2048 by 1536 pixels; 45° field of view
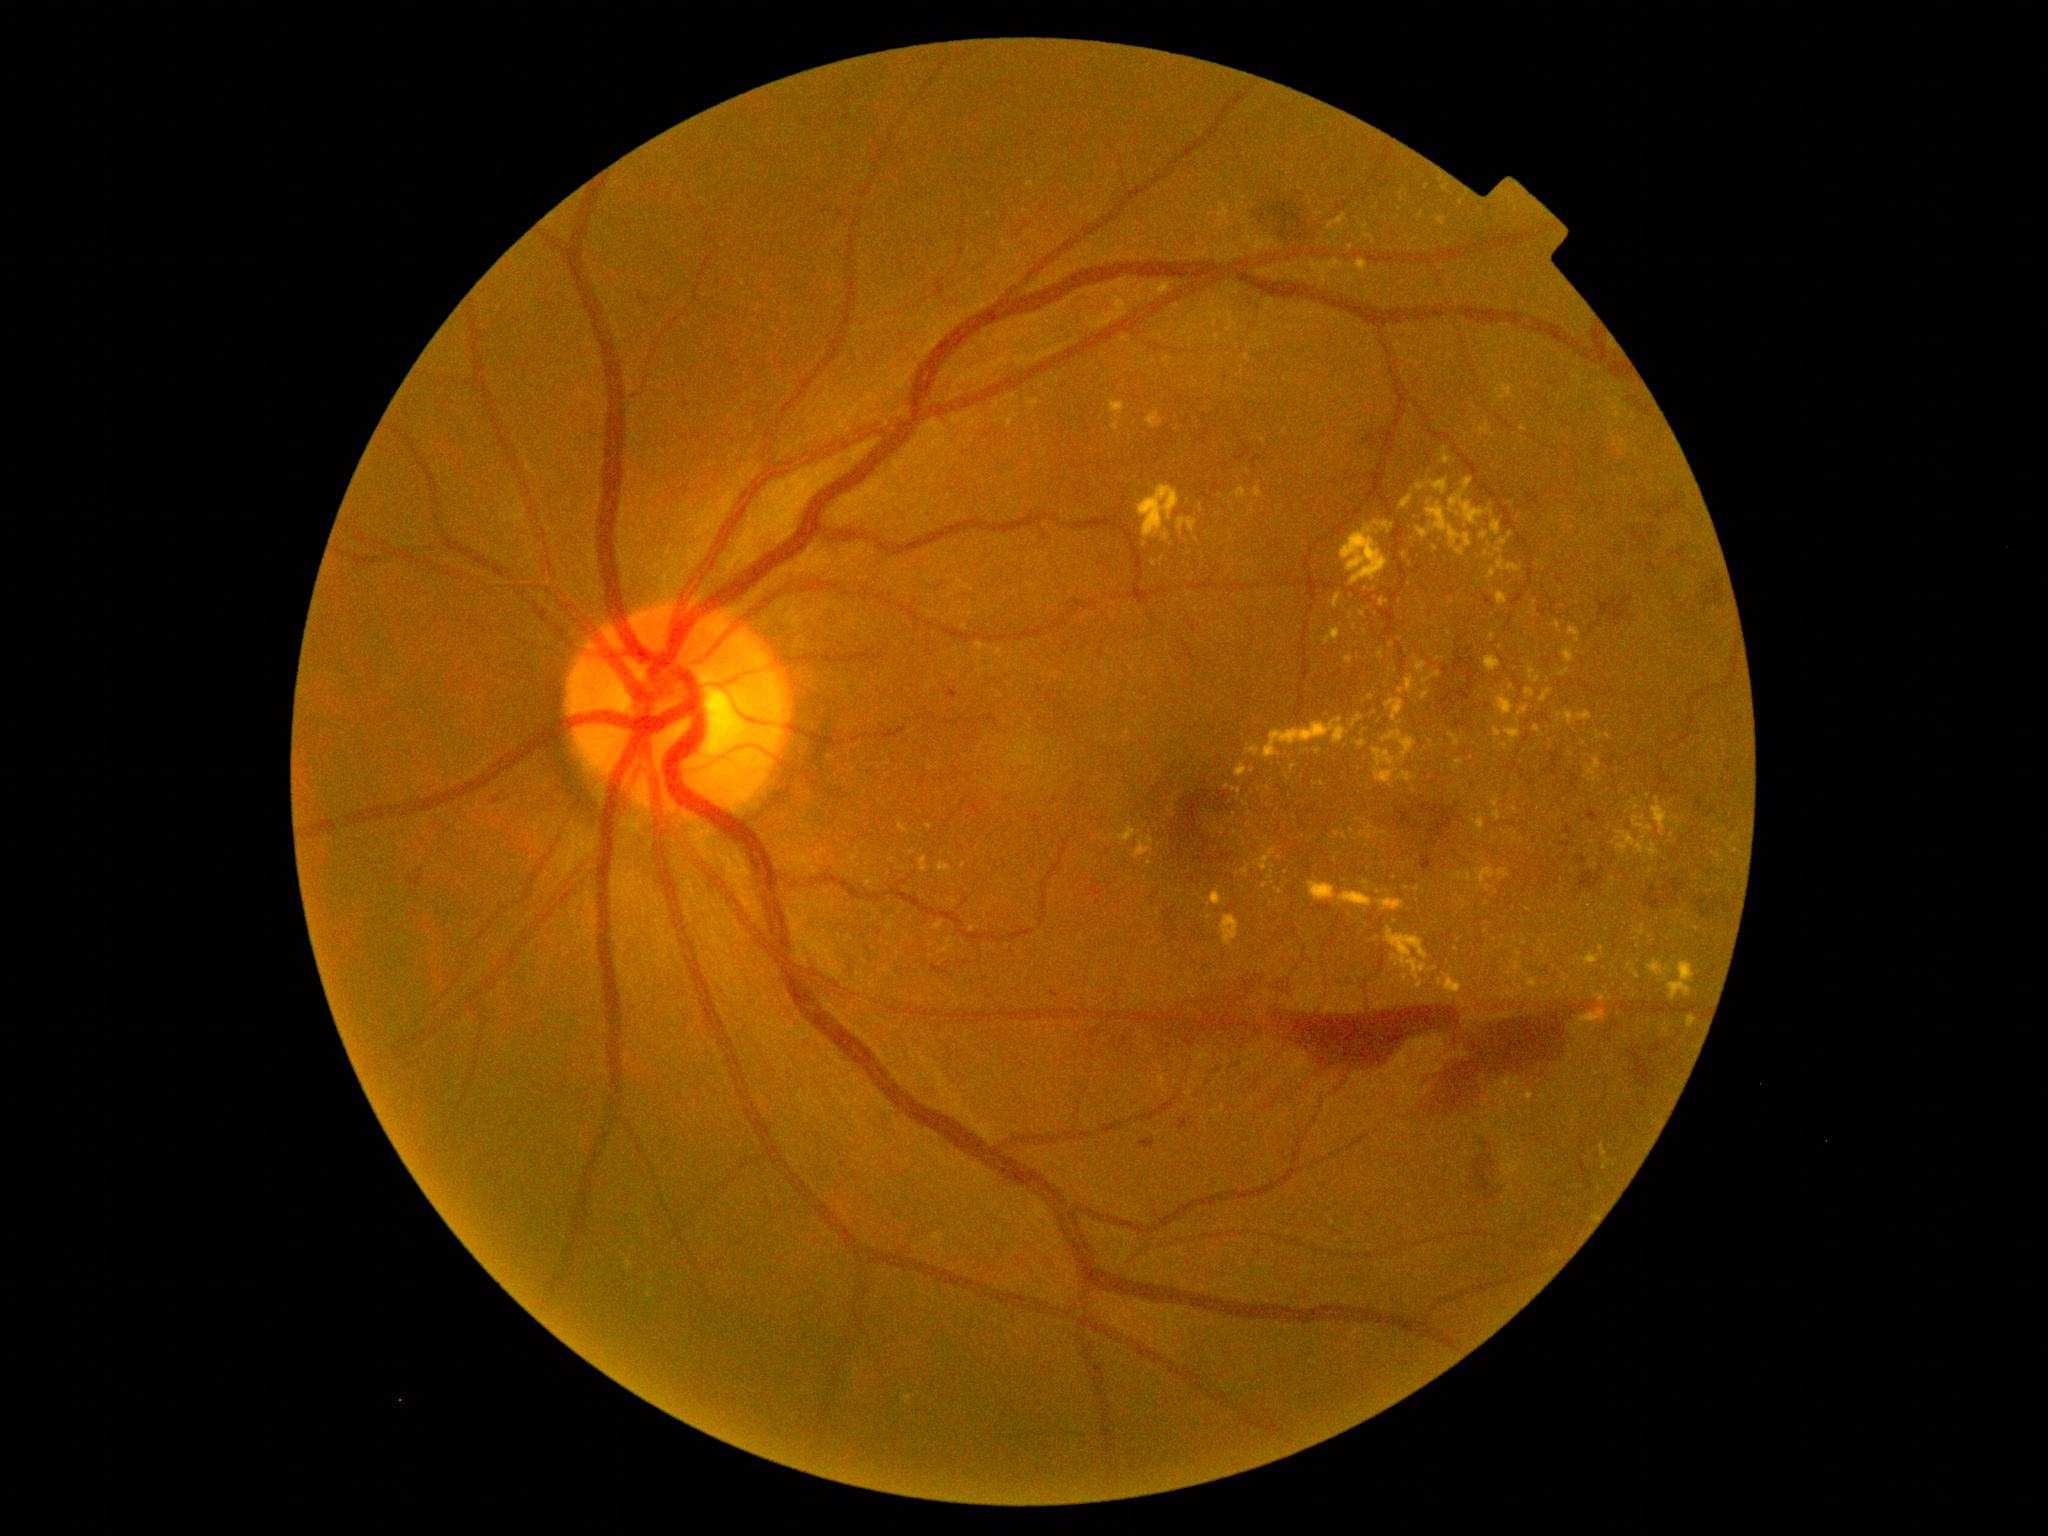
{"partial": true, "dr_grade": 4, "lesions": {"ex": [[1158, 283, 1172, 296], [1565, 713, 1575, 725], [1387, 928, 1428, 981], [1439, 217, 1446, 226], [1526, 689, 1535, 697], [1477, 818, 1484, 831], [1386, 699, 1404, 722], [1135, 842, 1152, 859], [1353, 714, 1364, 727]], "ex_small_centers": [[1415, 240], [1385, 833], [1637, 976], [1605, 1167], [1637, 807], [947, 949], [1595, 1218], [1438, 659], [1418, 890], [1221, 315]]}}